Wide-field fundus photograph from neonatal ROP screening.
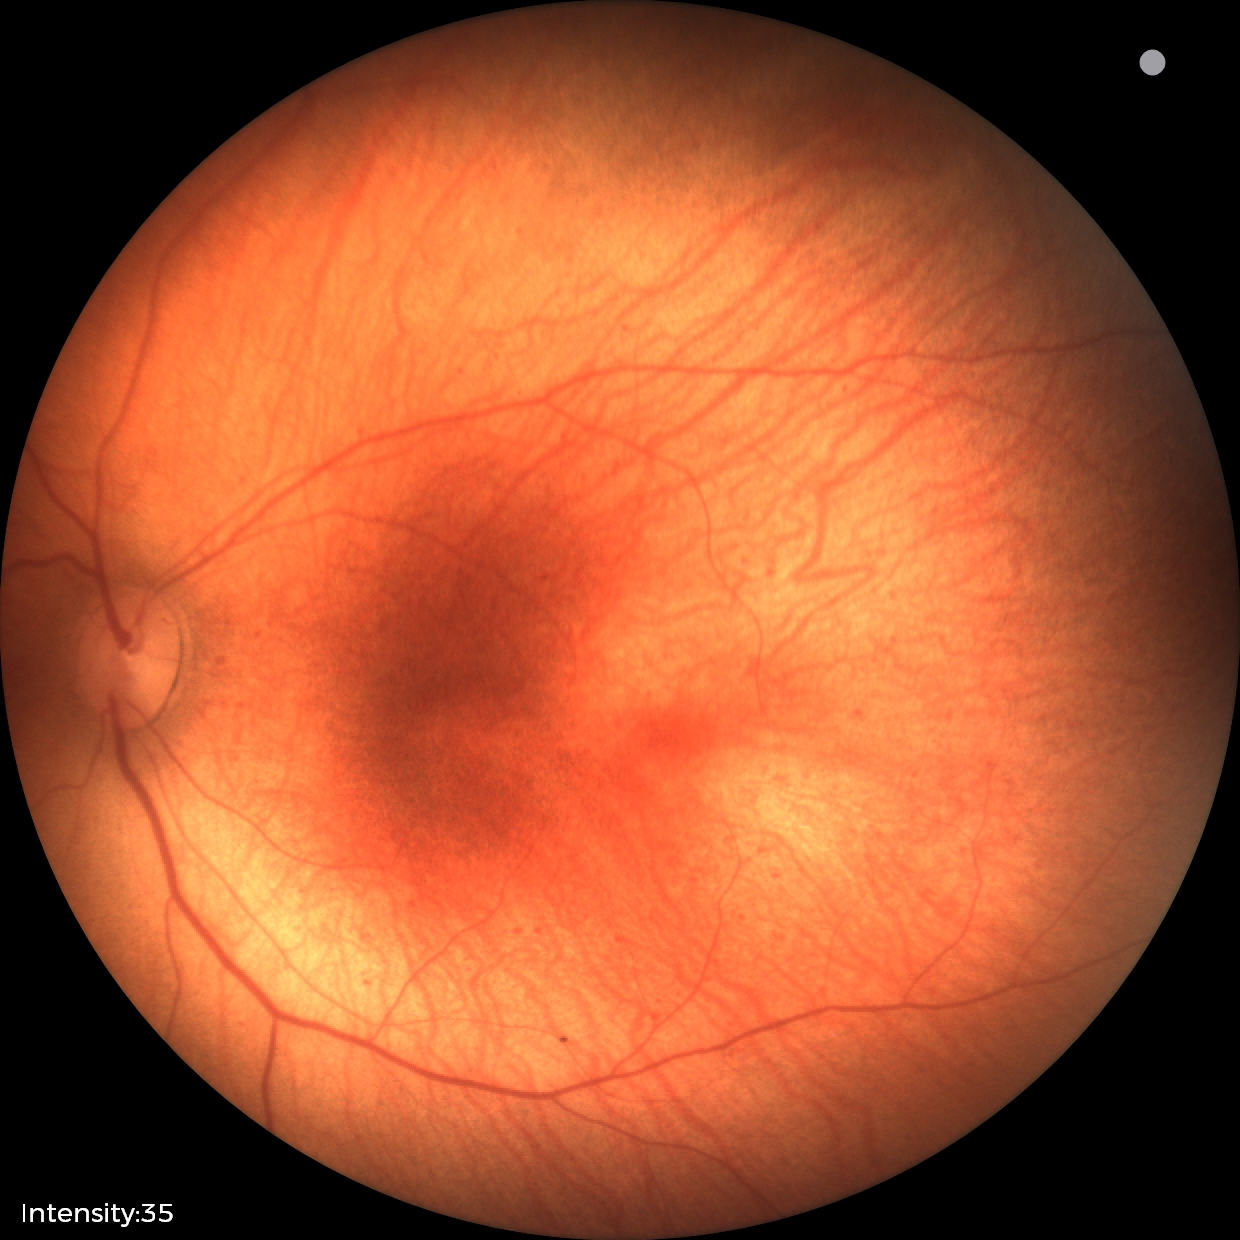
Assessment: physiological appearance.